No pharmacologic dilation · 45° FOV.
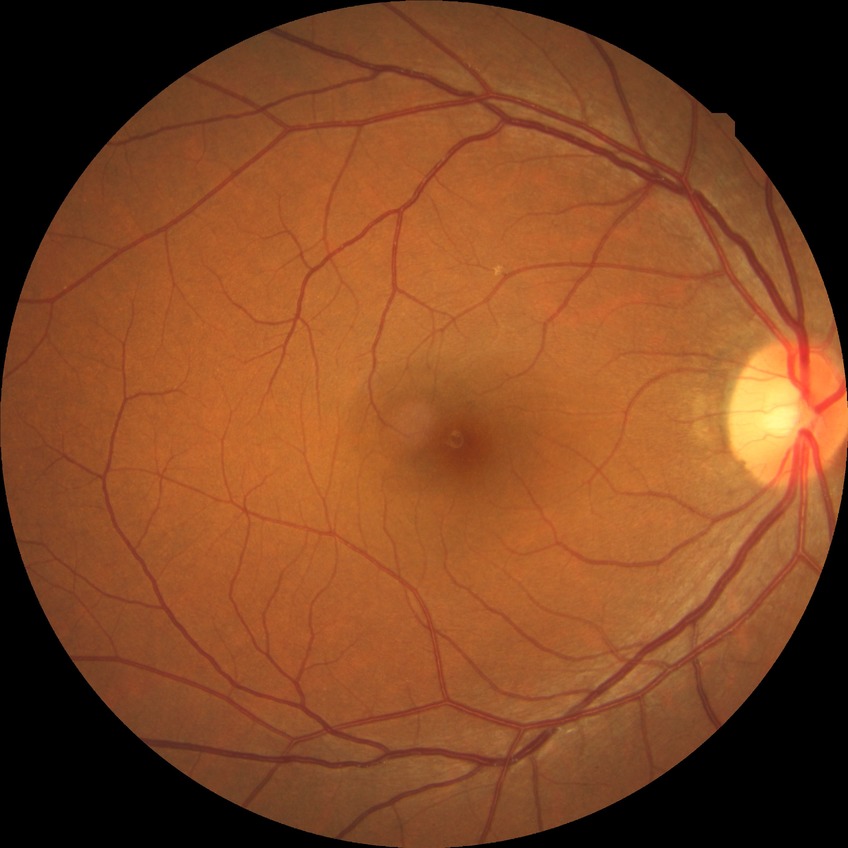

diabetic retinopathy stage: no diabetic retinopathy.